45 degree fundus photograph, no pharmacologic dilation, 848 by 848 pixels, retinal fundus photograph:
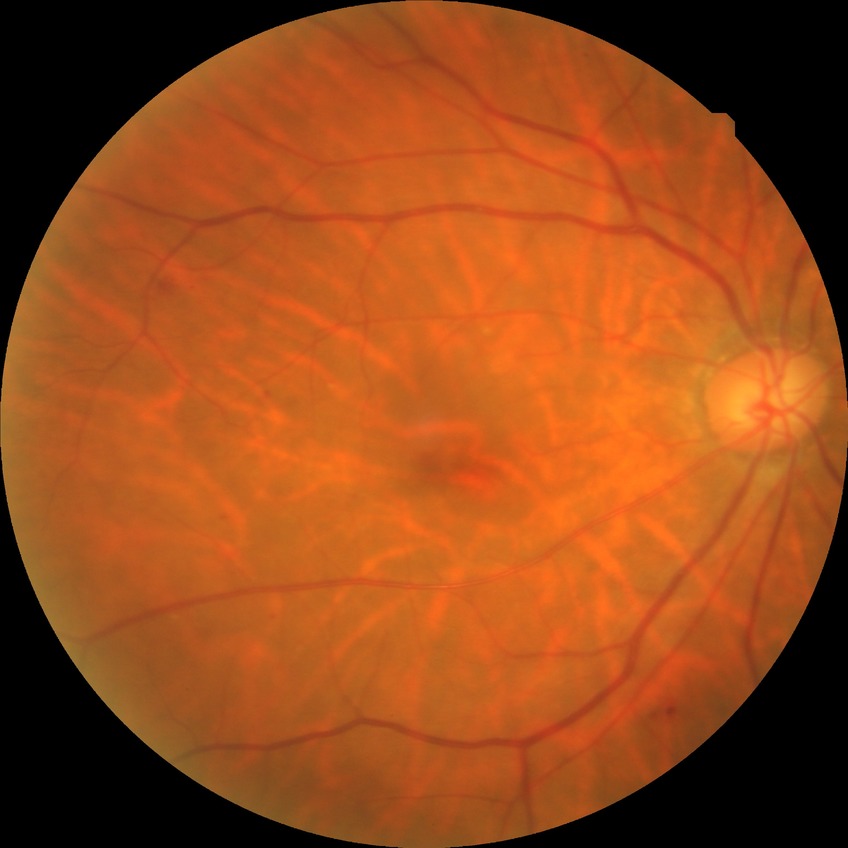 {"davis_grade": "simple diabetic retinopathy"}